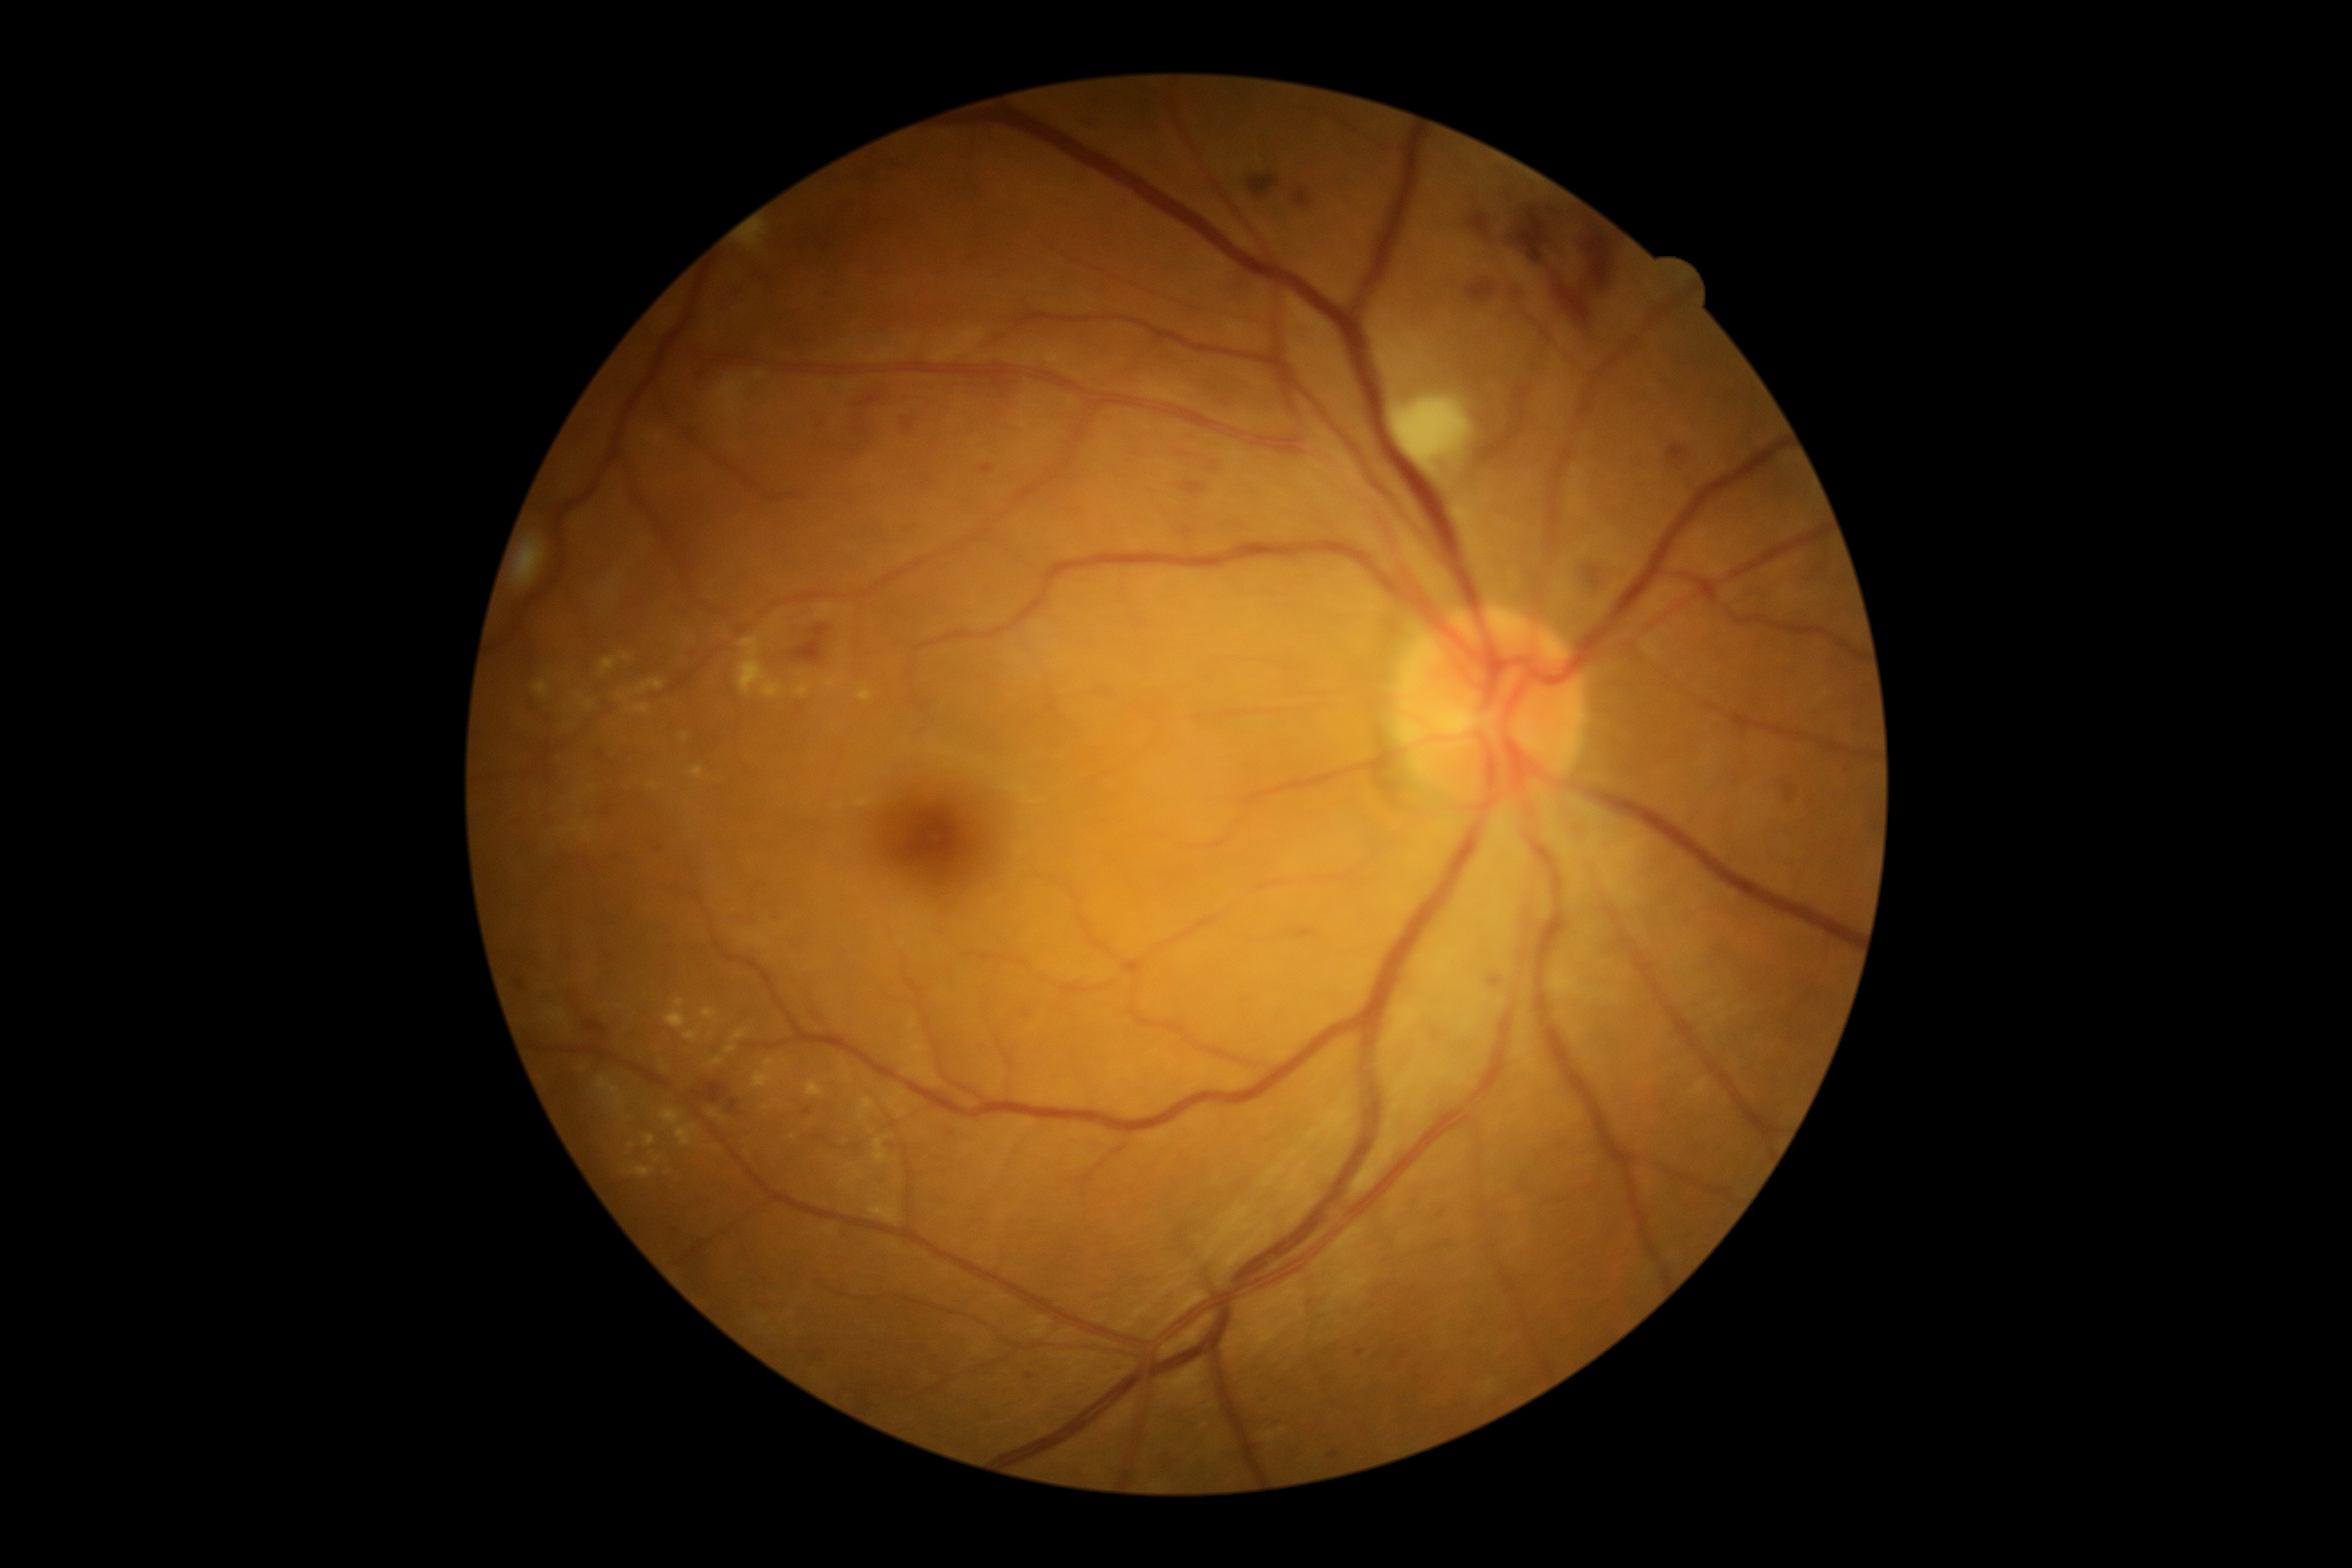
retinopathy: moderate non-proliferative diabetic retinopathy (grade 2) | DR class: non-proliferative diabetic retinopathy.